NIDEK AFC-230 fundus camera · retinal fundus photograph · 45° FOV · image size 848x848 · no pharmacologic dilation — 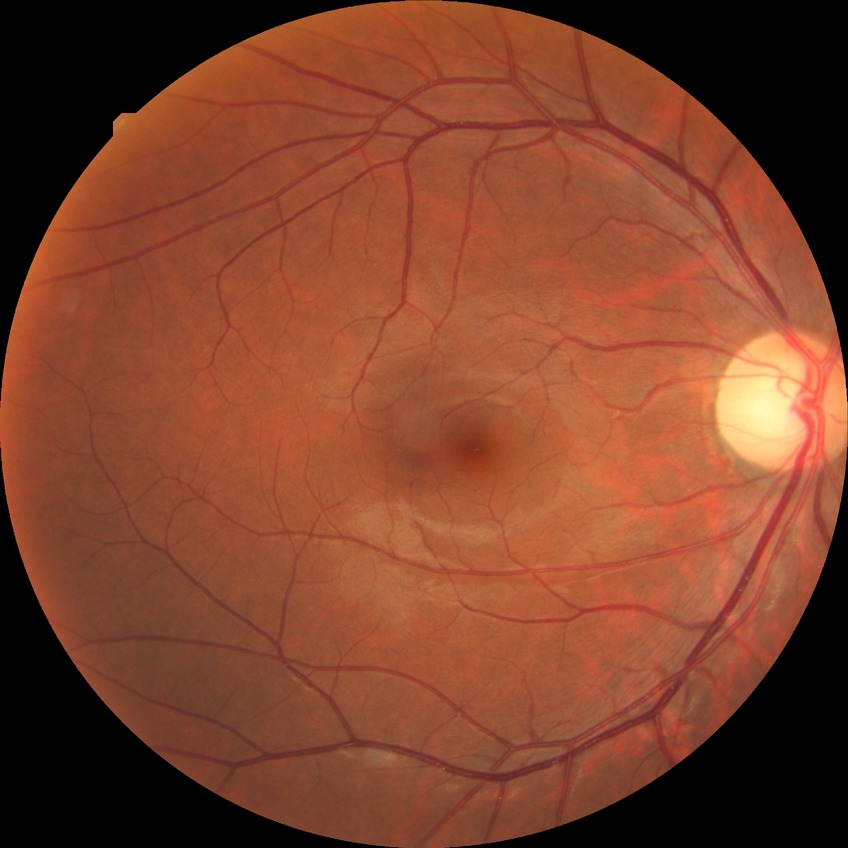
davis_grade: no diabetic retinopathy (NDR)